Color fundus photograph
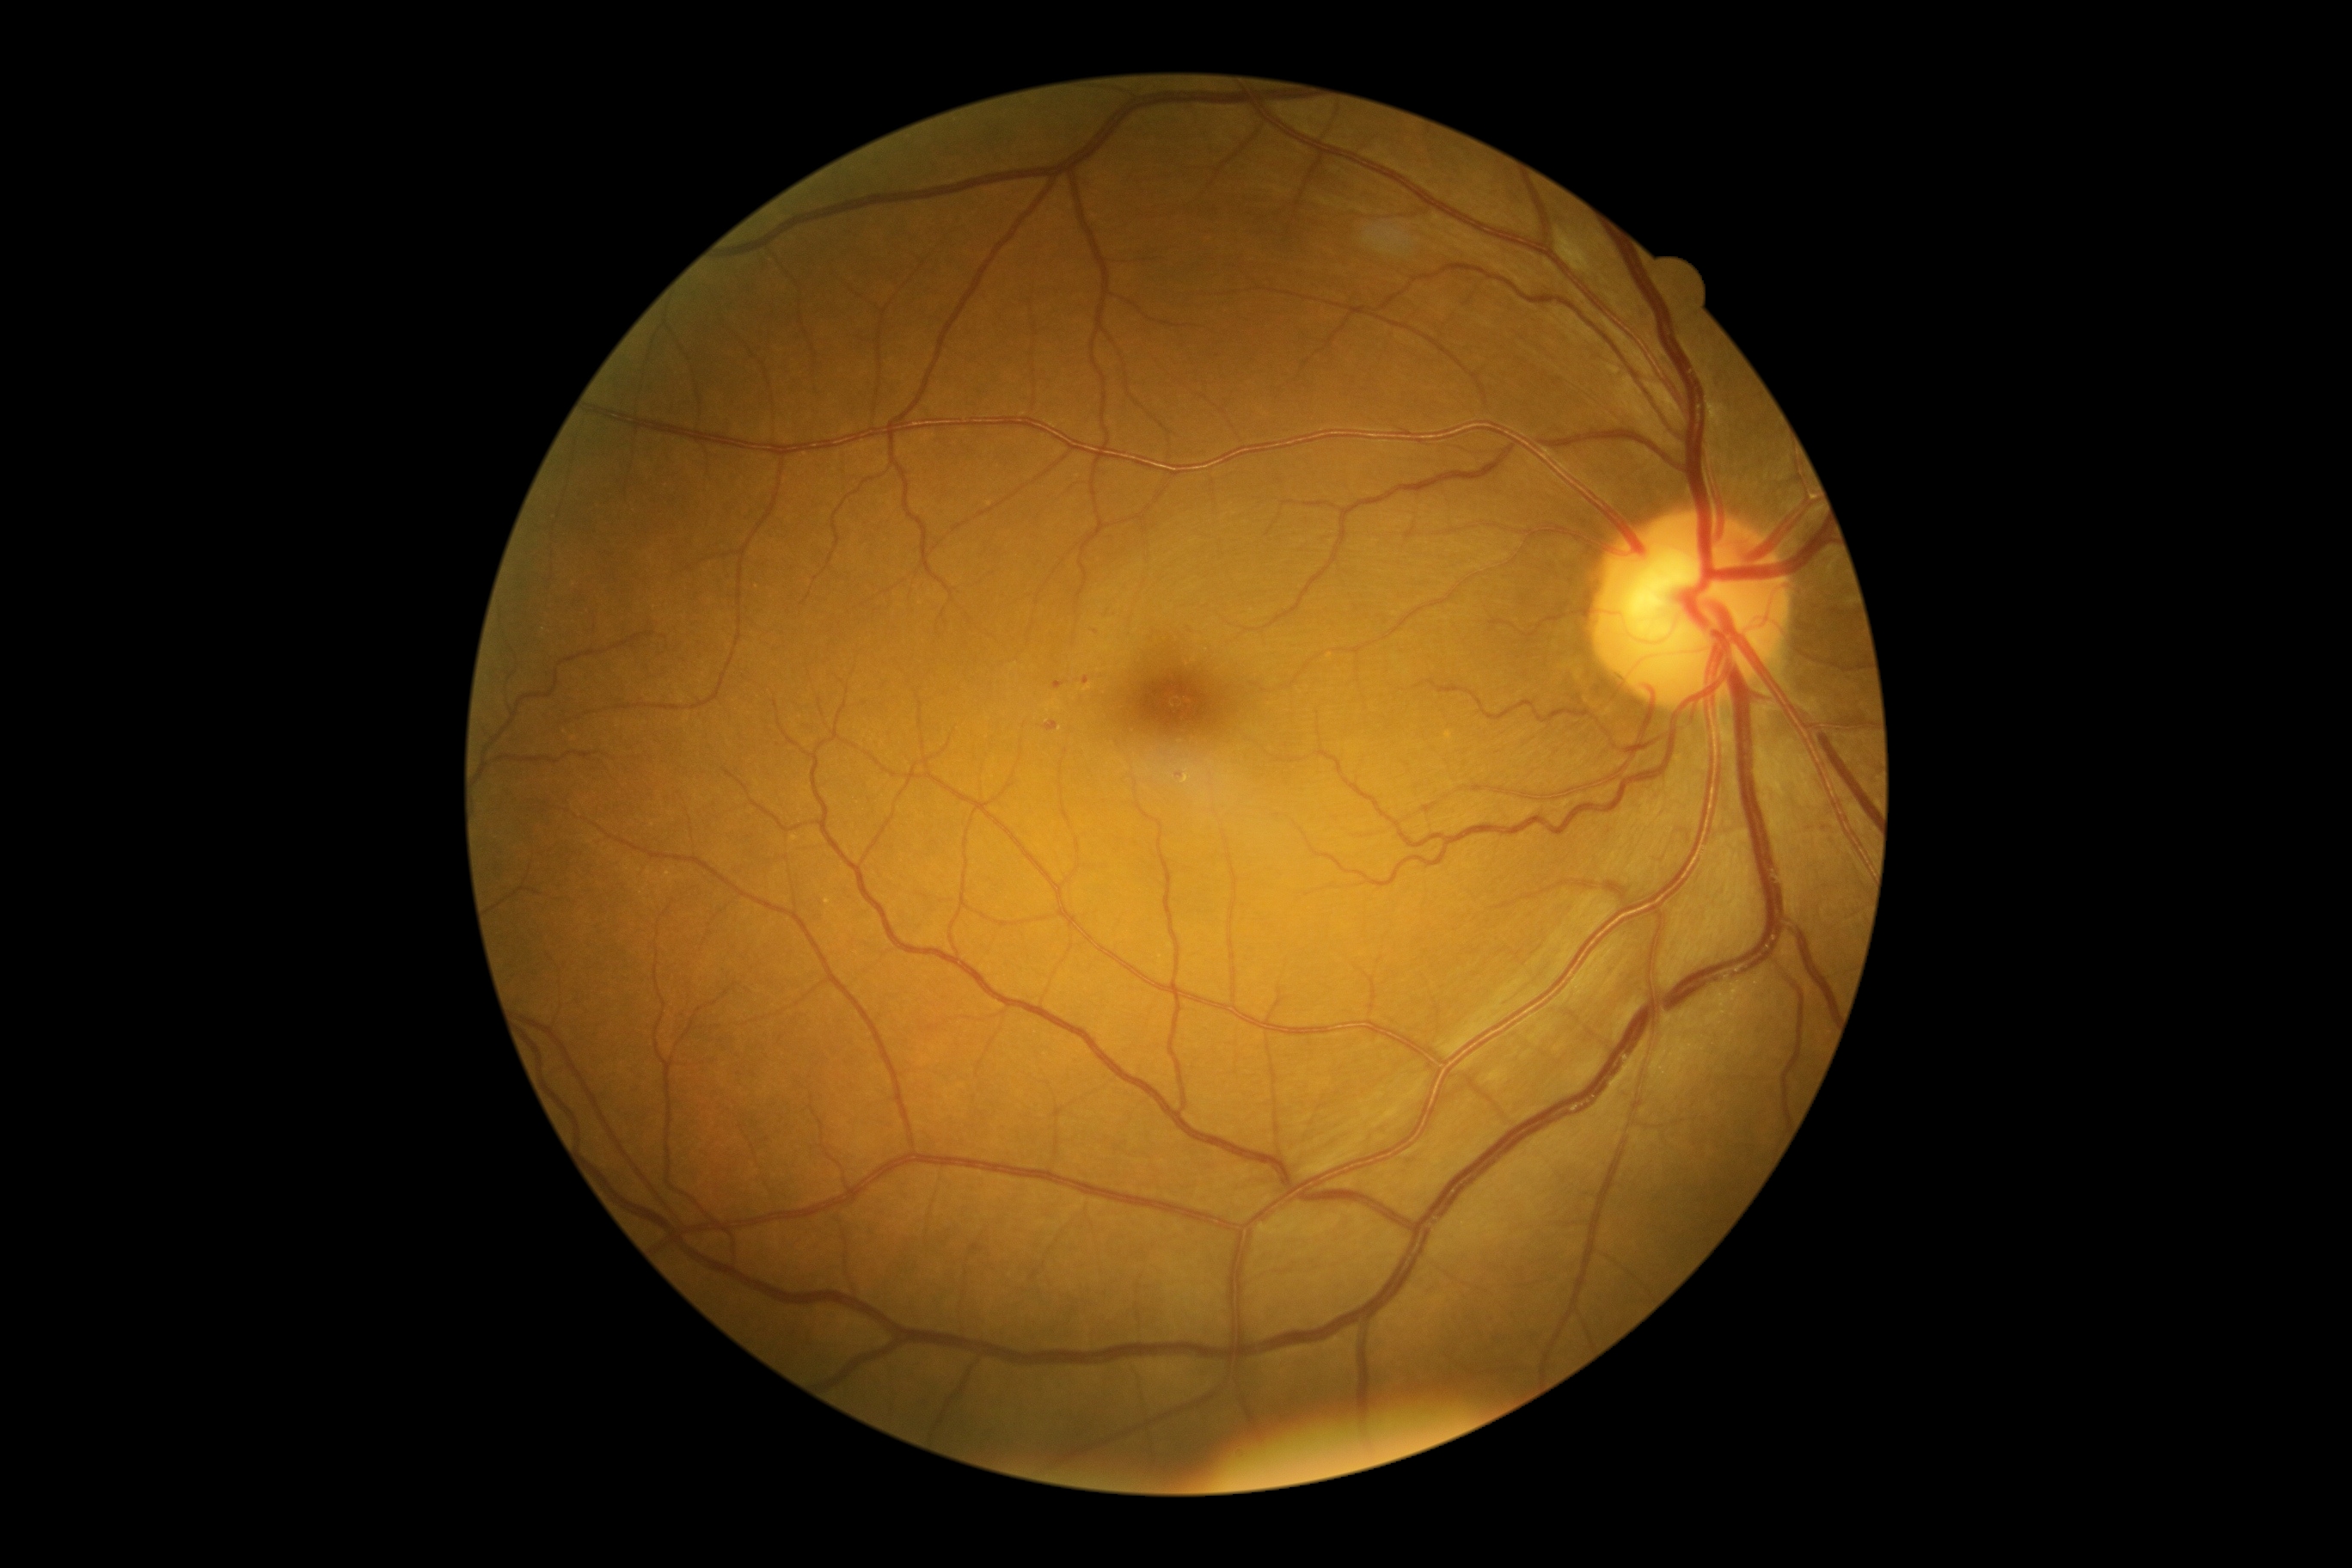
DR class@non-proliferative diabetic retinopathy, diabetic retinopathy@2.